240x240px, non-mydriatic, cropped to the optic nerve head.
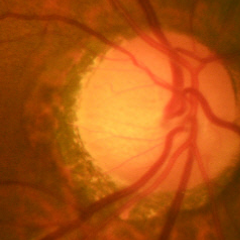
Diagnosis: no signs of glaucoma.